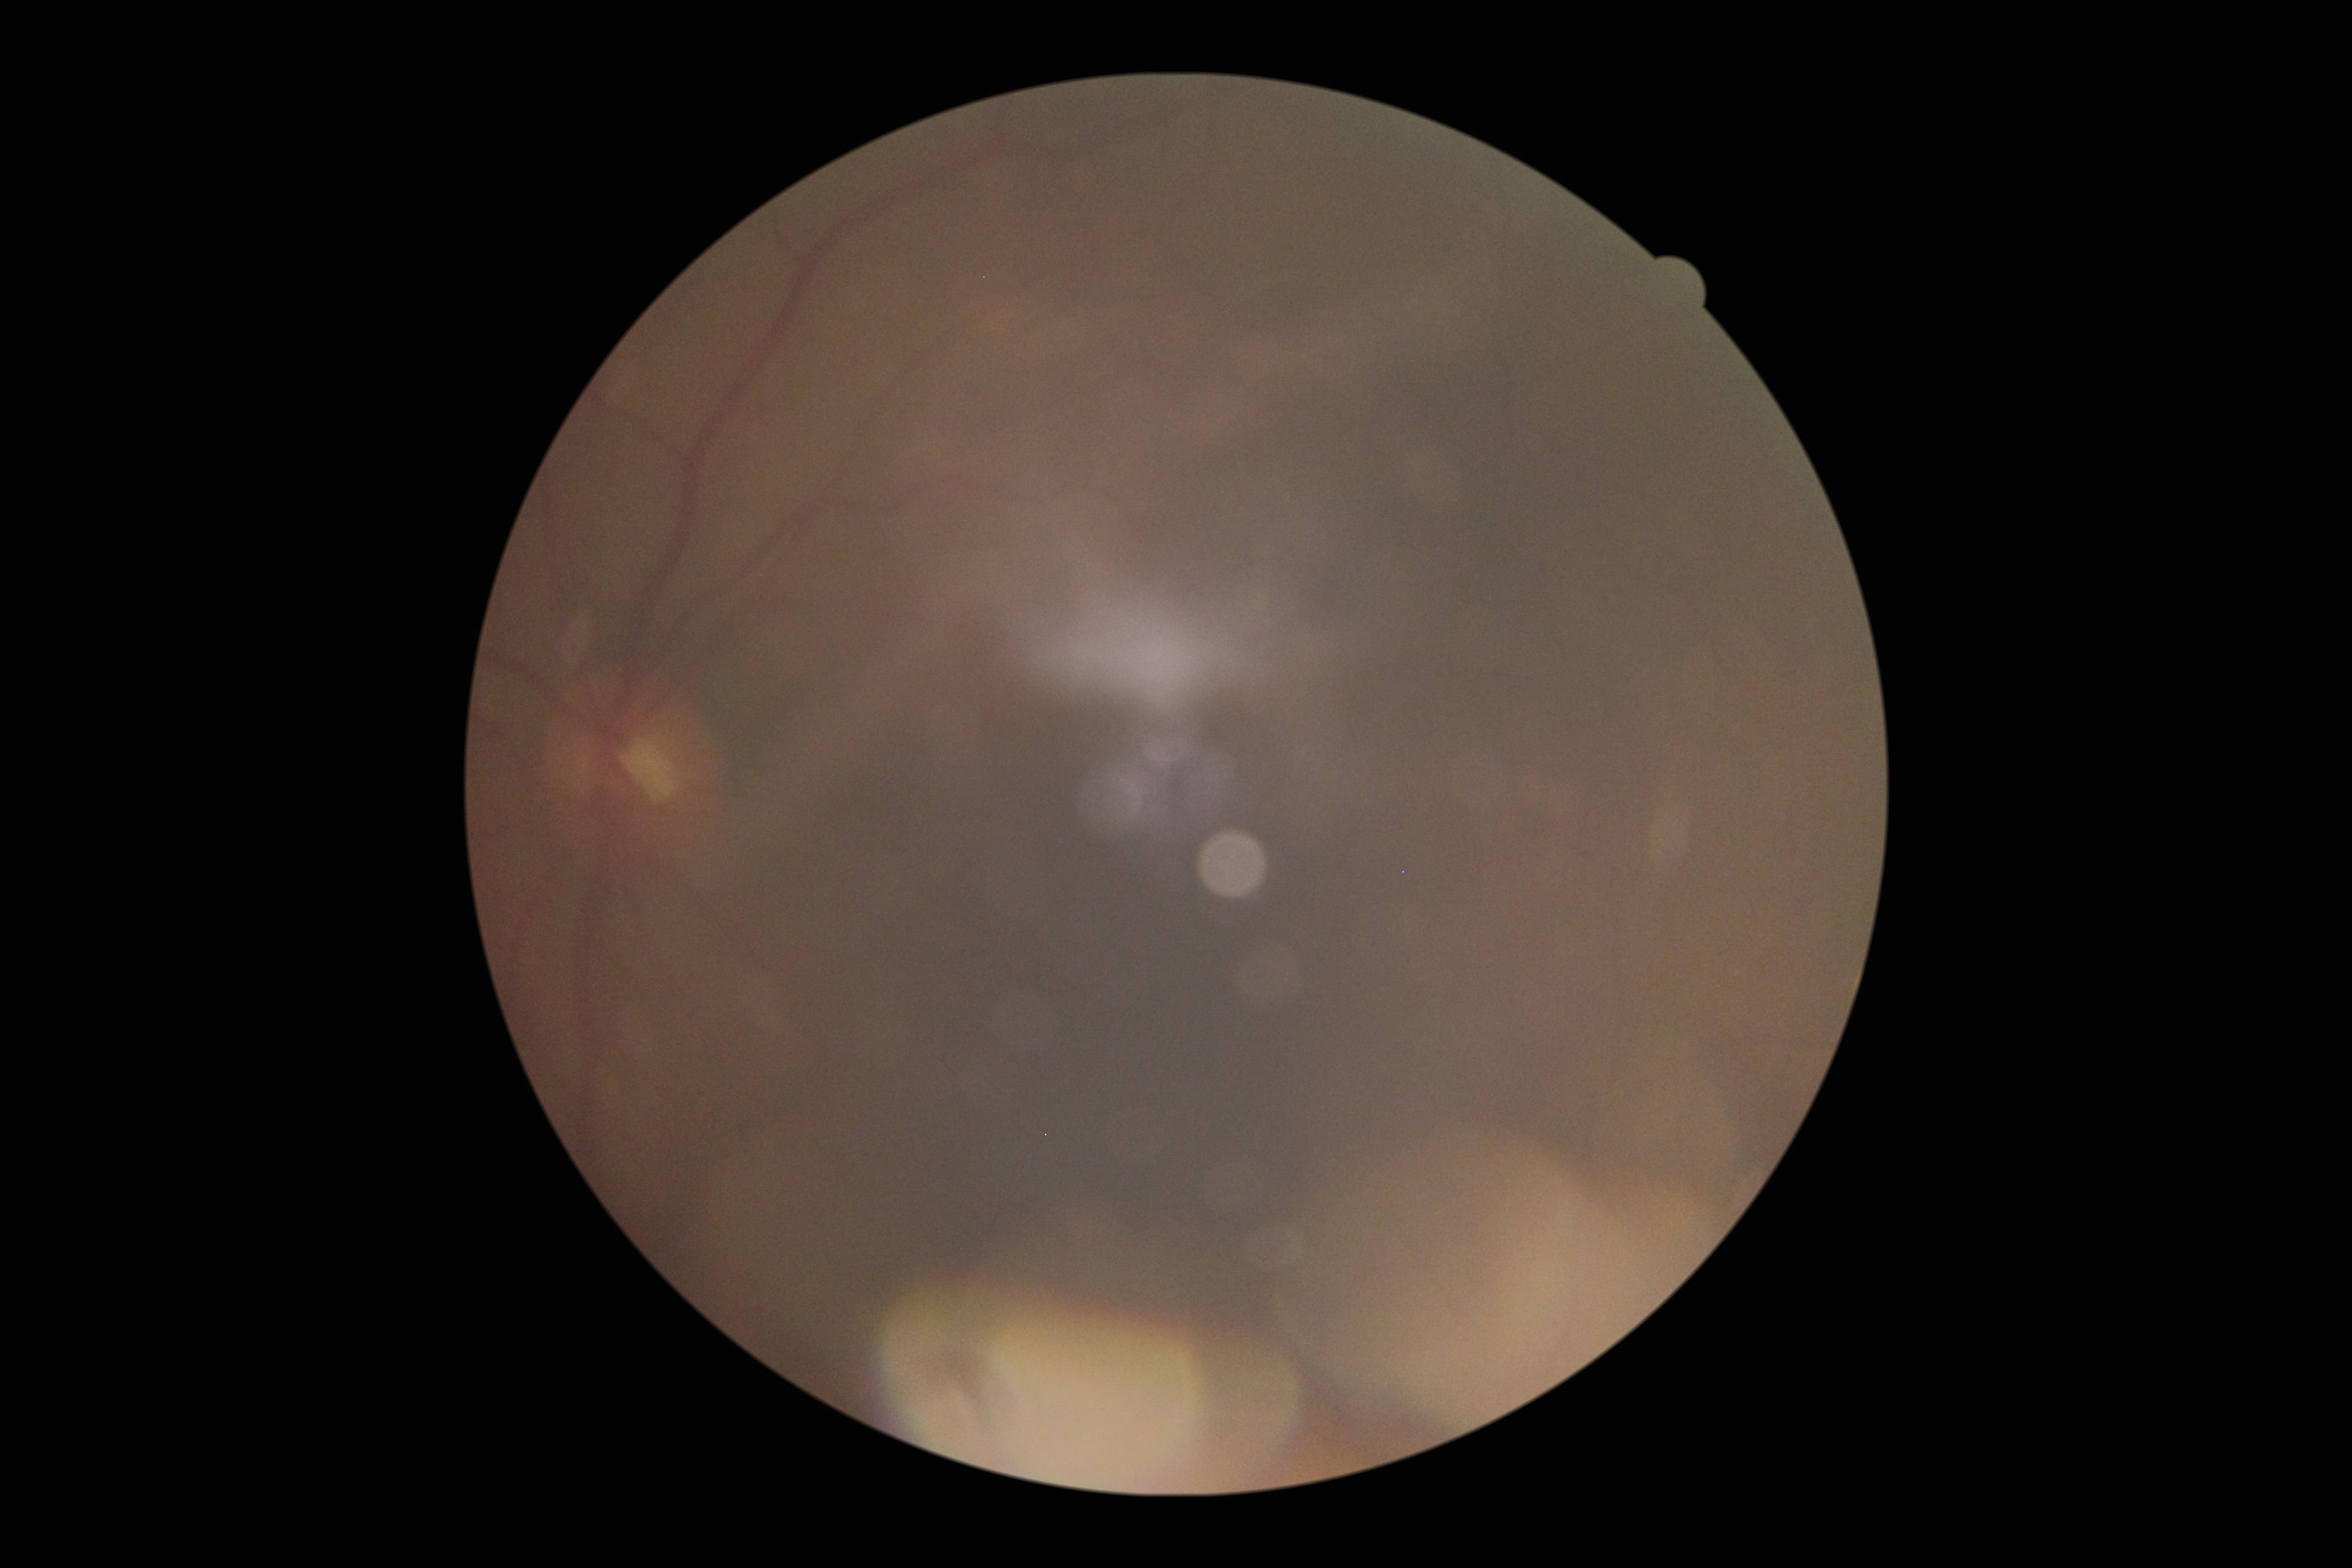 Diabetic retinopathy (DR) is ungradable.